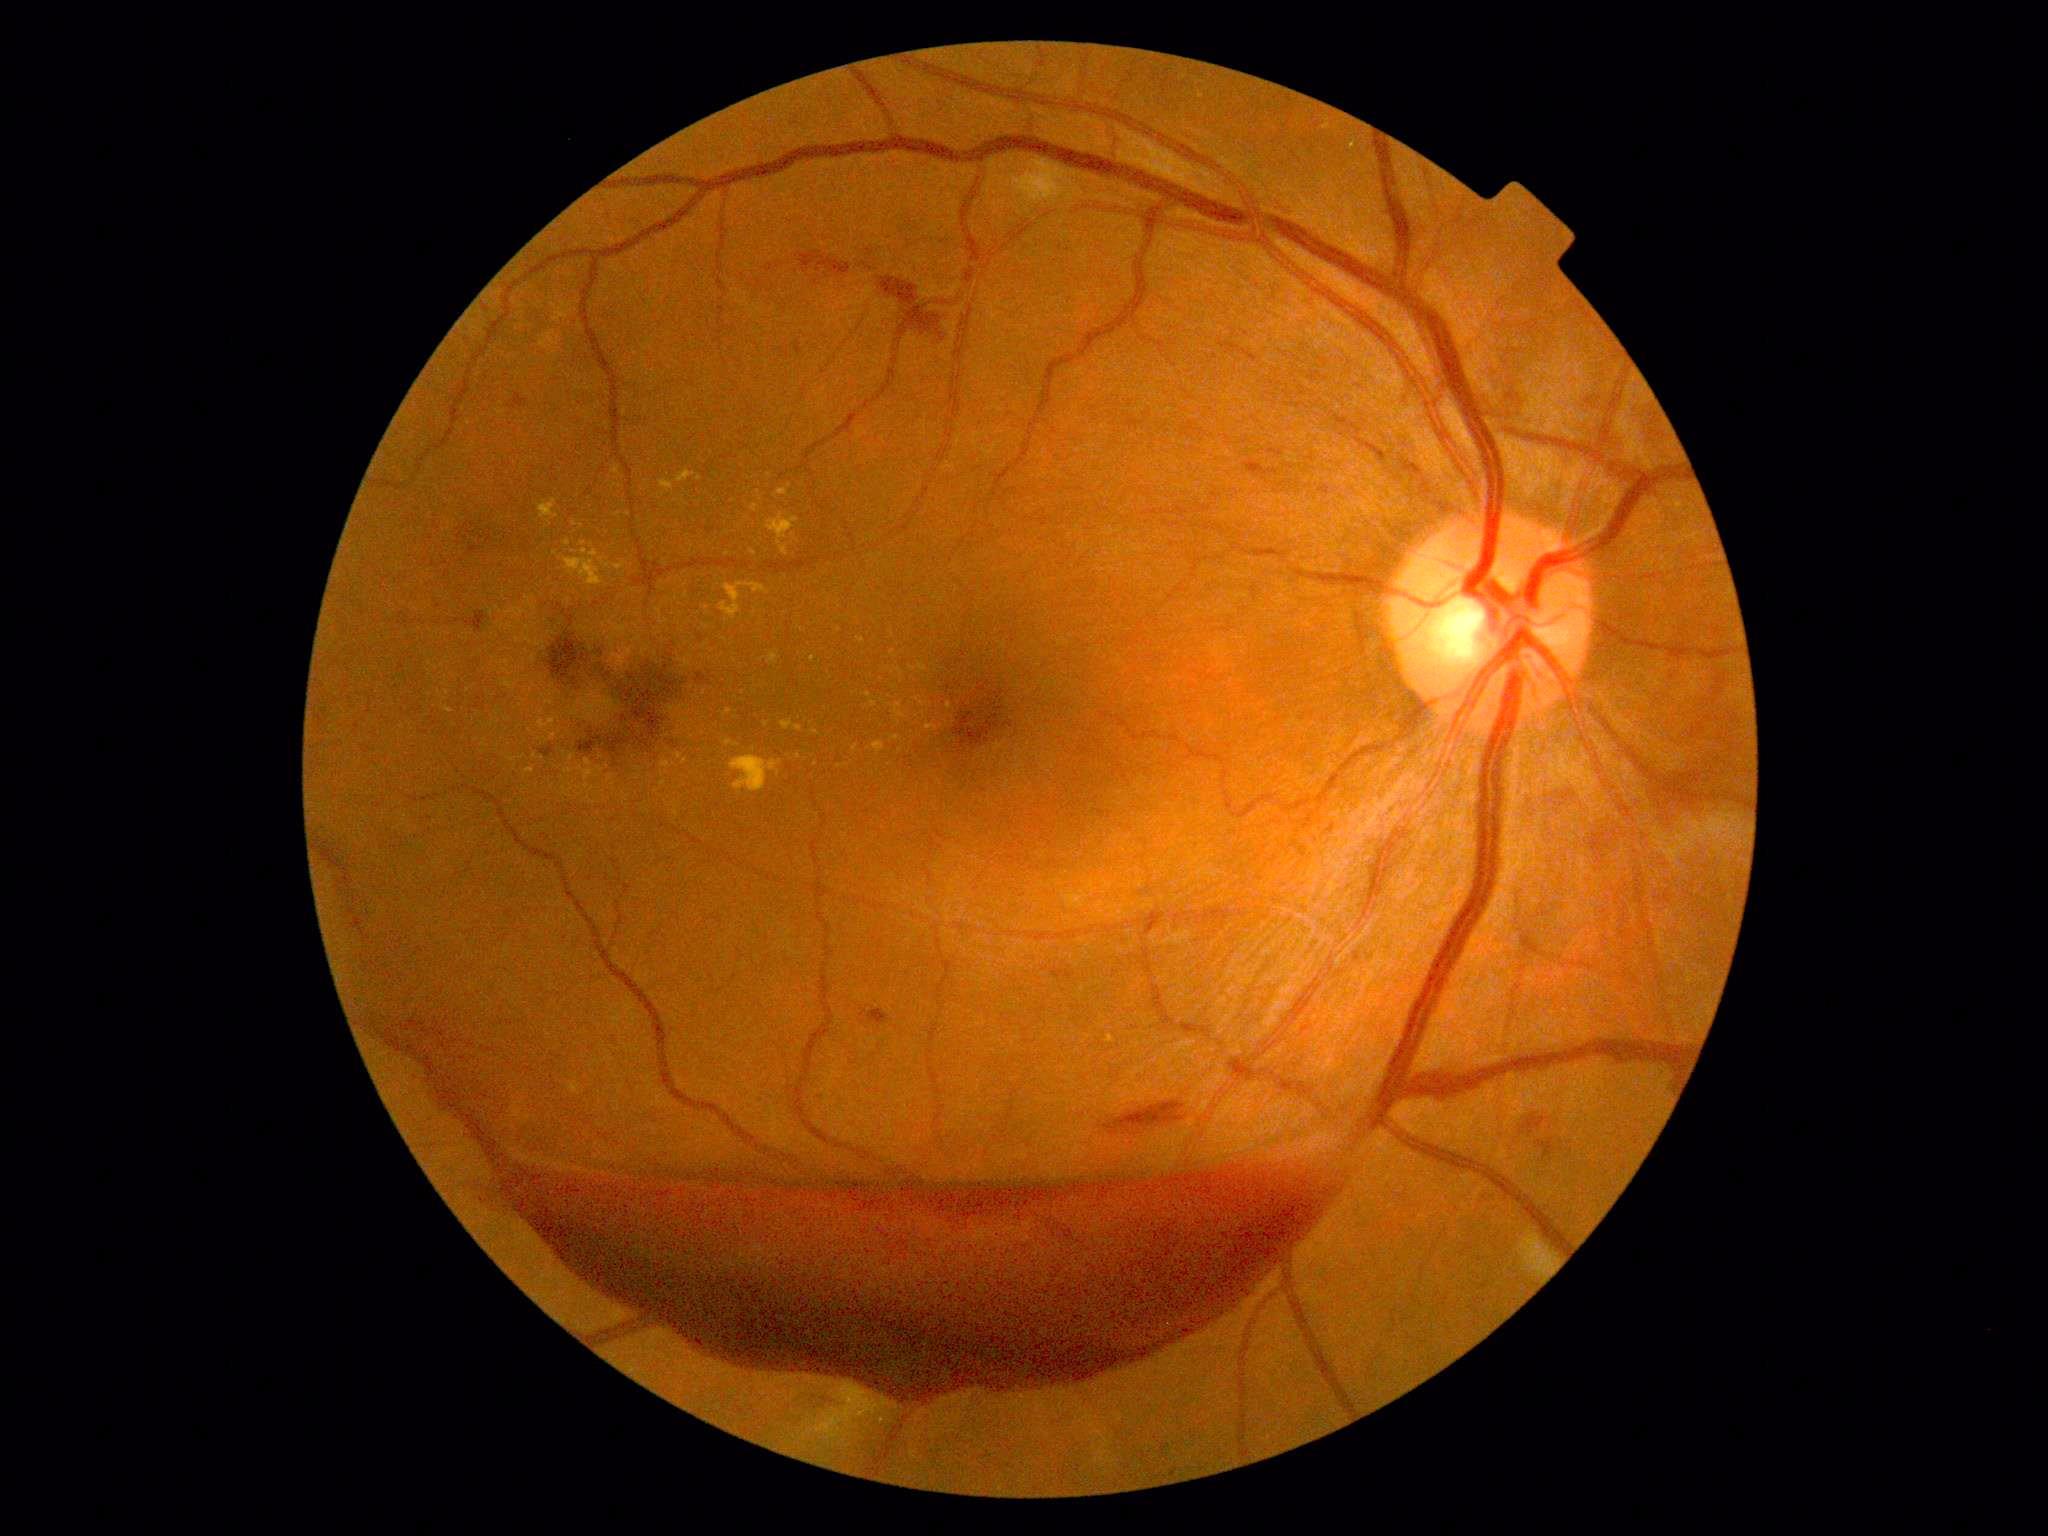

DR severity is PDR (grade 4)
Selected lesions:
EXs (more not shown) = {"left": 724, "top": 741, "right": 738, "bottom": 748} | {"left": 896, "top": 668, "right": 903, "bottom": 677} | {"left": 607, "top": 775, "right": 615, "bottom": 784} | {"left": 909, "top": 663, "right": 928, "bottom": 673} | {"left": 674, "top": 754, "right": 689, "bottom": 765} | {"left": 539, "top": 499, "right": 559, "bottom": 526} | {"left": 838, "top": 764, "right": 848, "bottom": 769}
Additional small EXs near [763,659] | [916,699] | [507,672] | [439,693] | [553,738] | [706,609] | [759,493] | [549,704] | [546,740] | [869,695]